45° field of view.
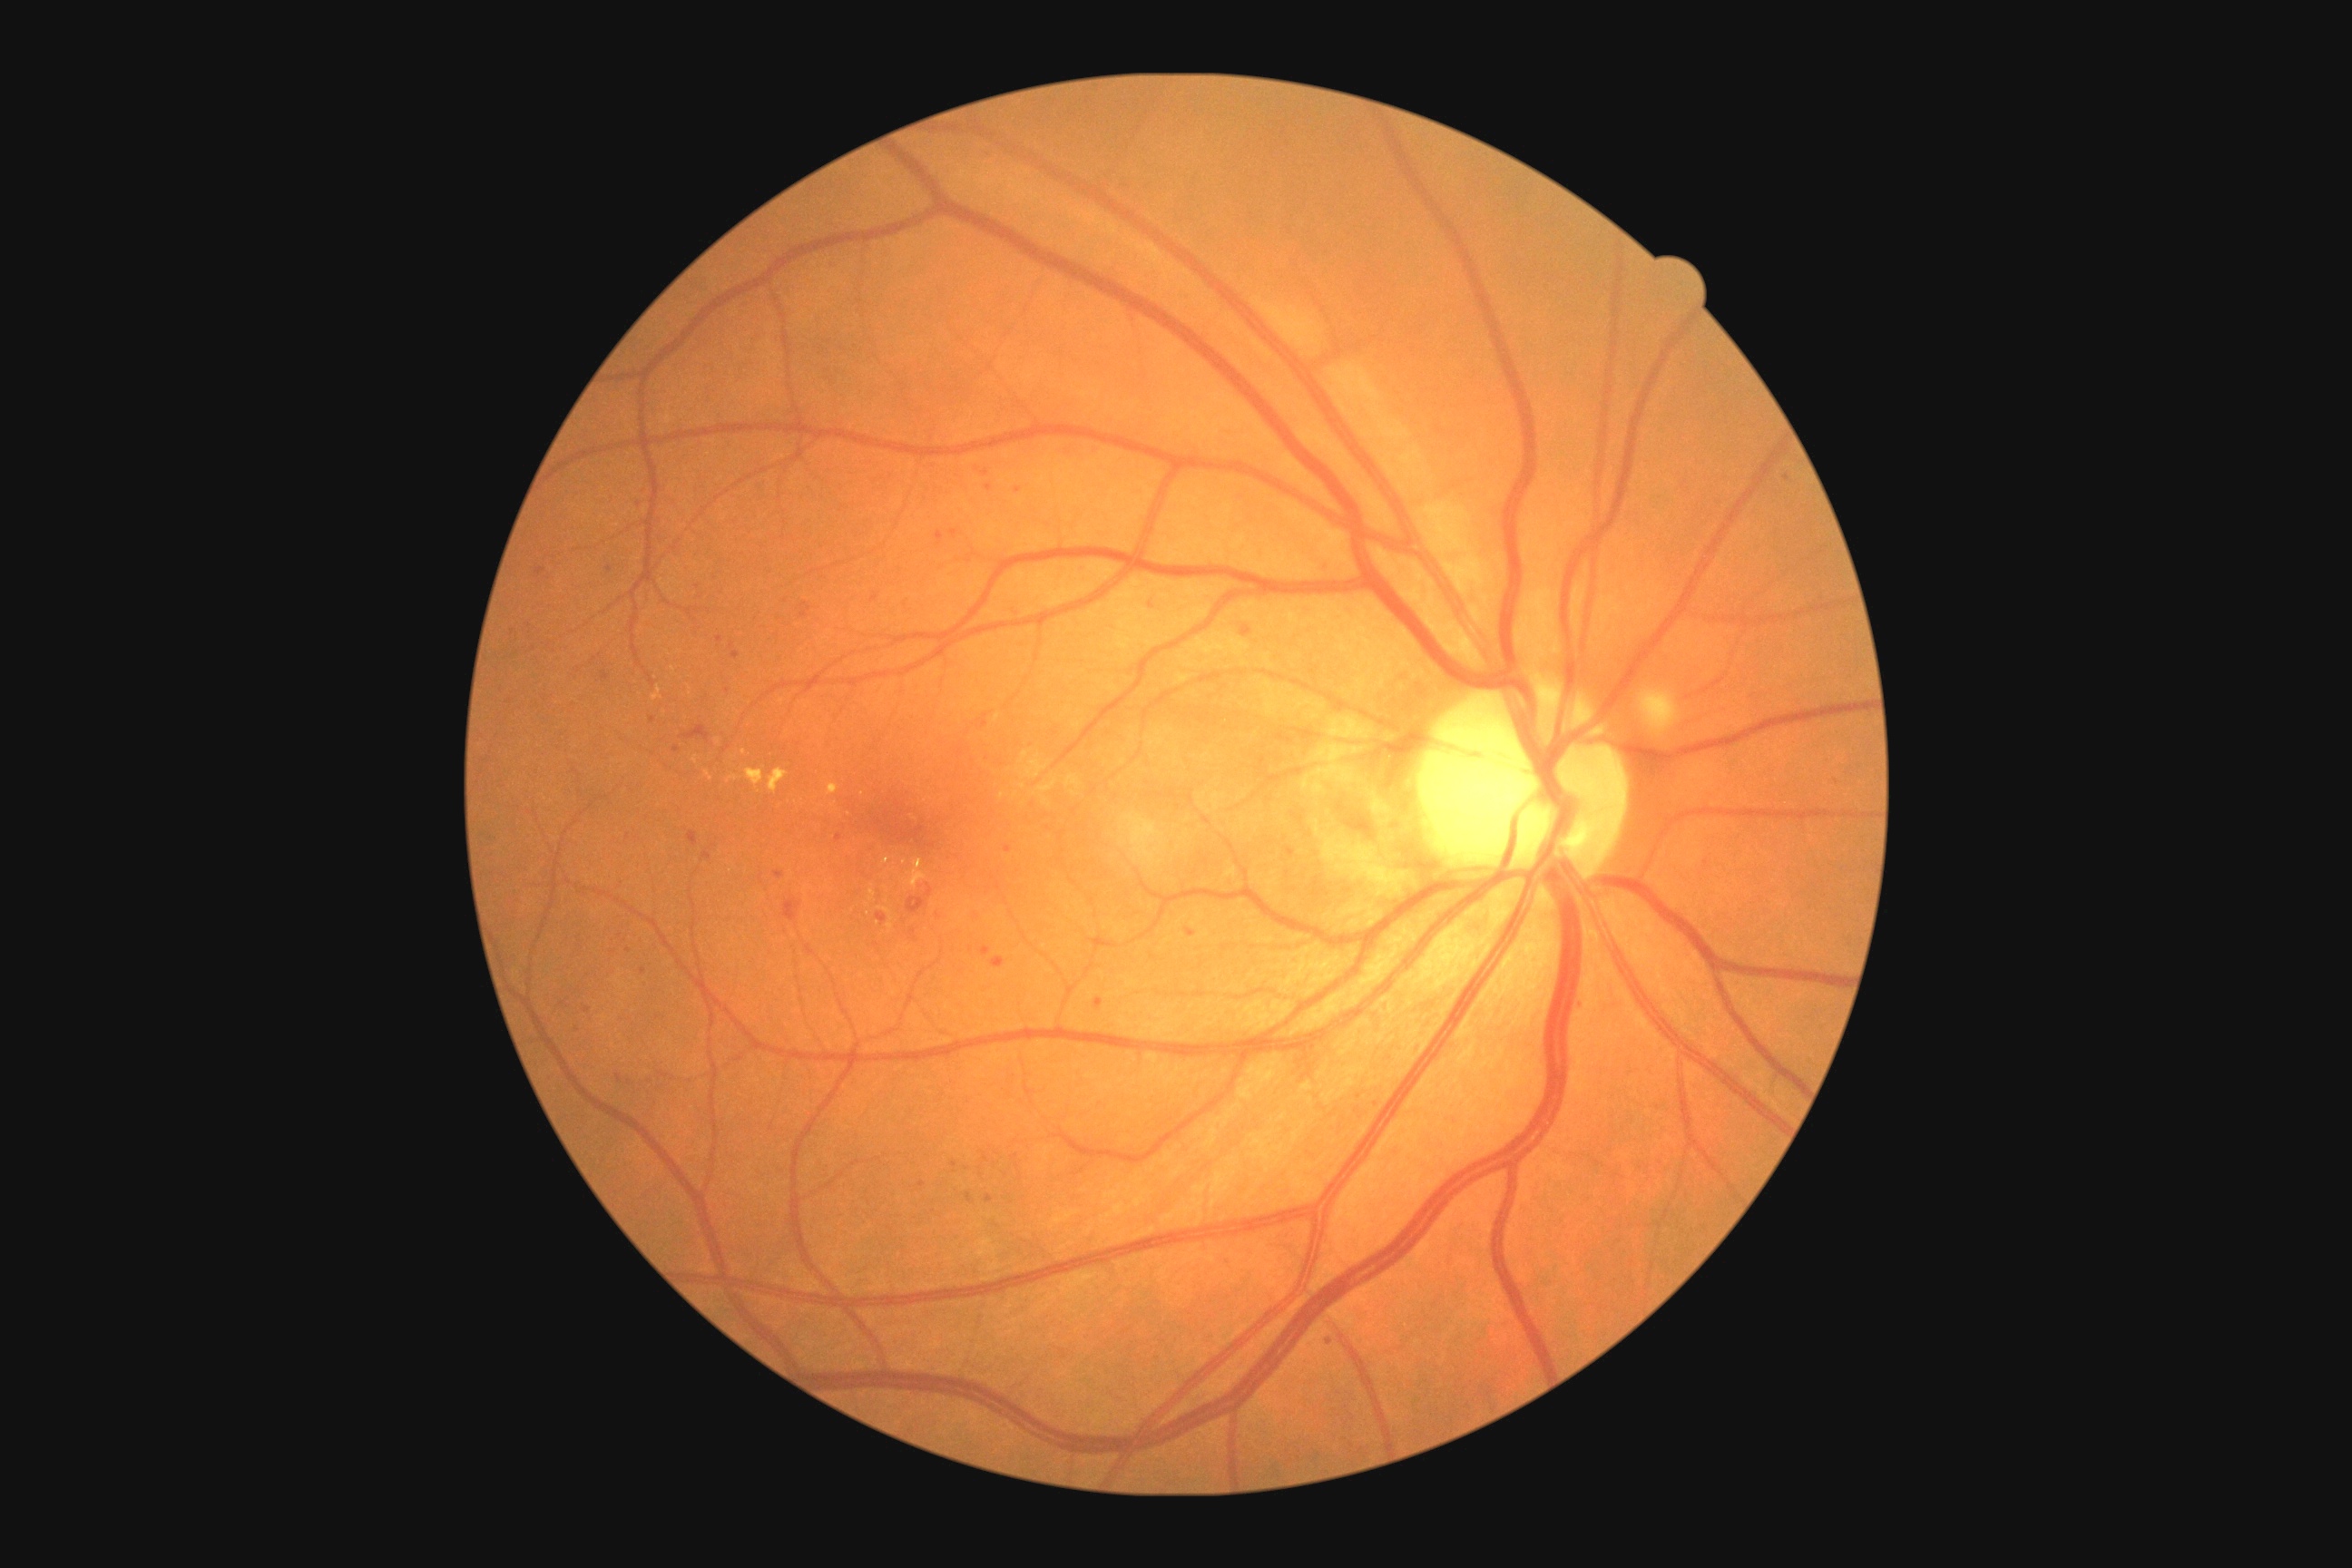
partial: true
dr_grade: 2
dr_grade_name: moderate NPDR
lesions:
  ma:
    - Rect(1015, 489, 1023, 495)
    - Rect(730, 643, 734, 651)
    - Rect(602, 672, 609, 681)
    - Rect(986, 484, 994, 491)
    - Rect(583, 1008, 591, 1014)
    - Rect(732, 652, 740, 660)
    - Rect(876, 914, 888, 925)
    - Rect(972, 910, 981, 919)
    - Rect(981, 714, 988, 729)
    - Rect(1186, 928, 1197, 937)
    - Rect(966, 1193, 972, 1202)
  ma_small_centers:
    - 875:599
    - 954:1165
    - 653:719
    - 578:1030
    - 1329:1342